Modified Davis classification · without pupil dilation · 848x848px · NIDEK AFC-230 · posterior pole color fundus photograph · 45-degree field of view — 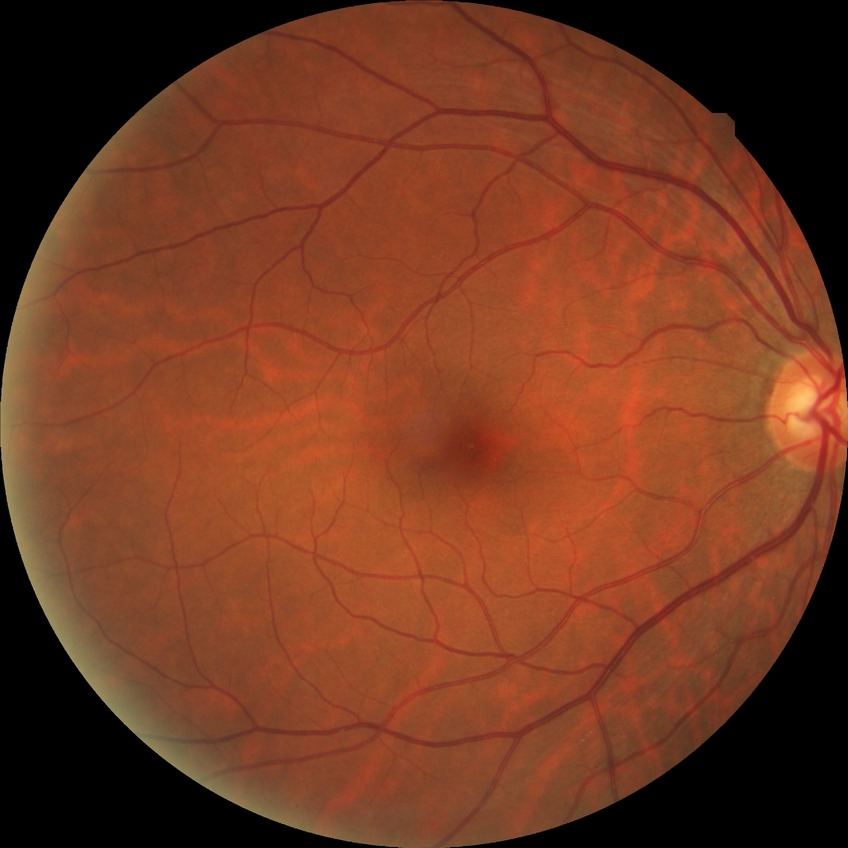 Modified Davis classification: no diabetic retinopathy.